Image size 2352x1568, 45° FOV — 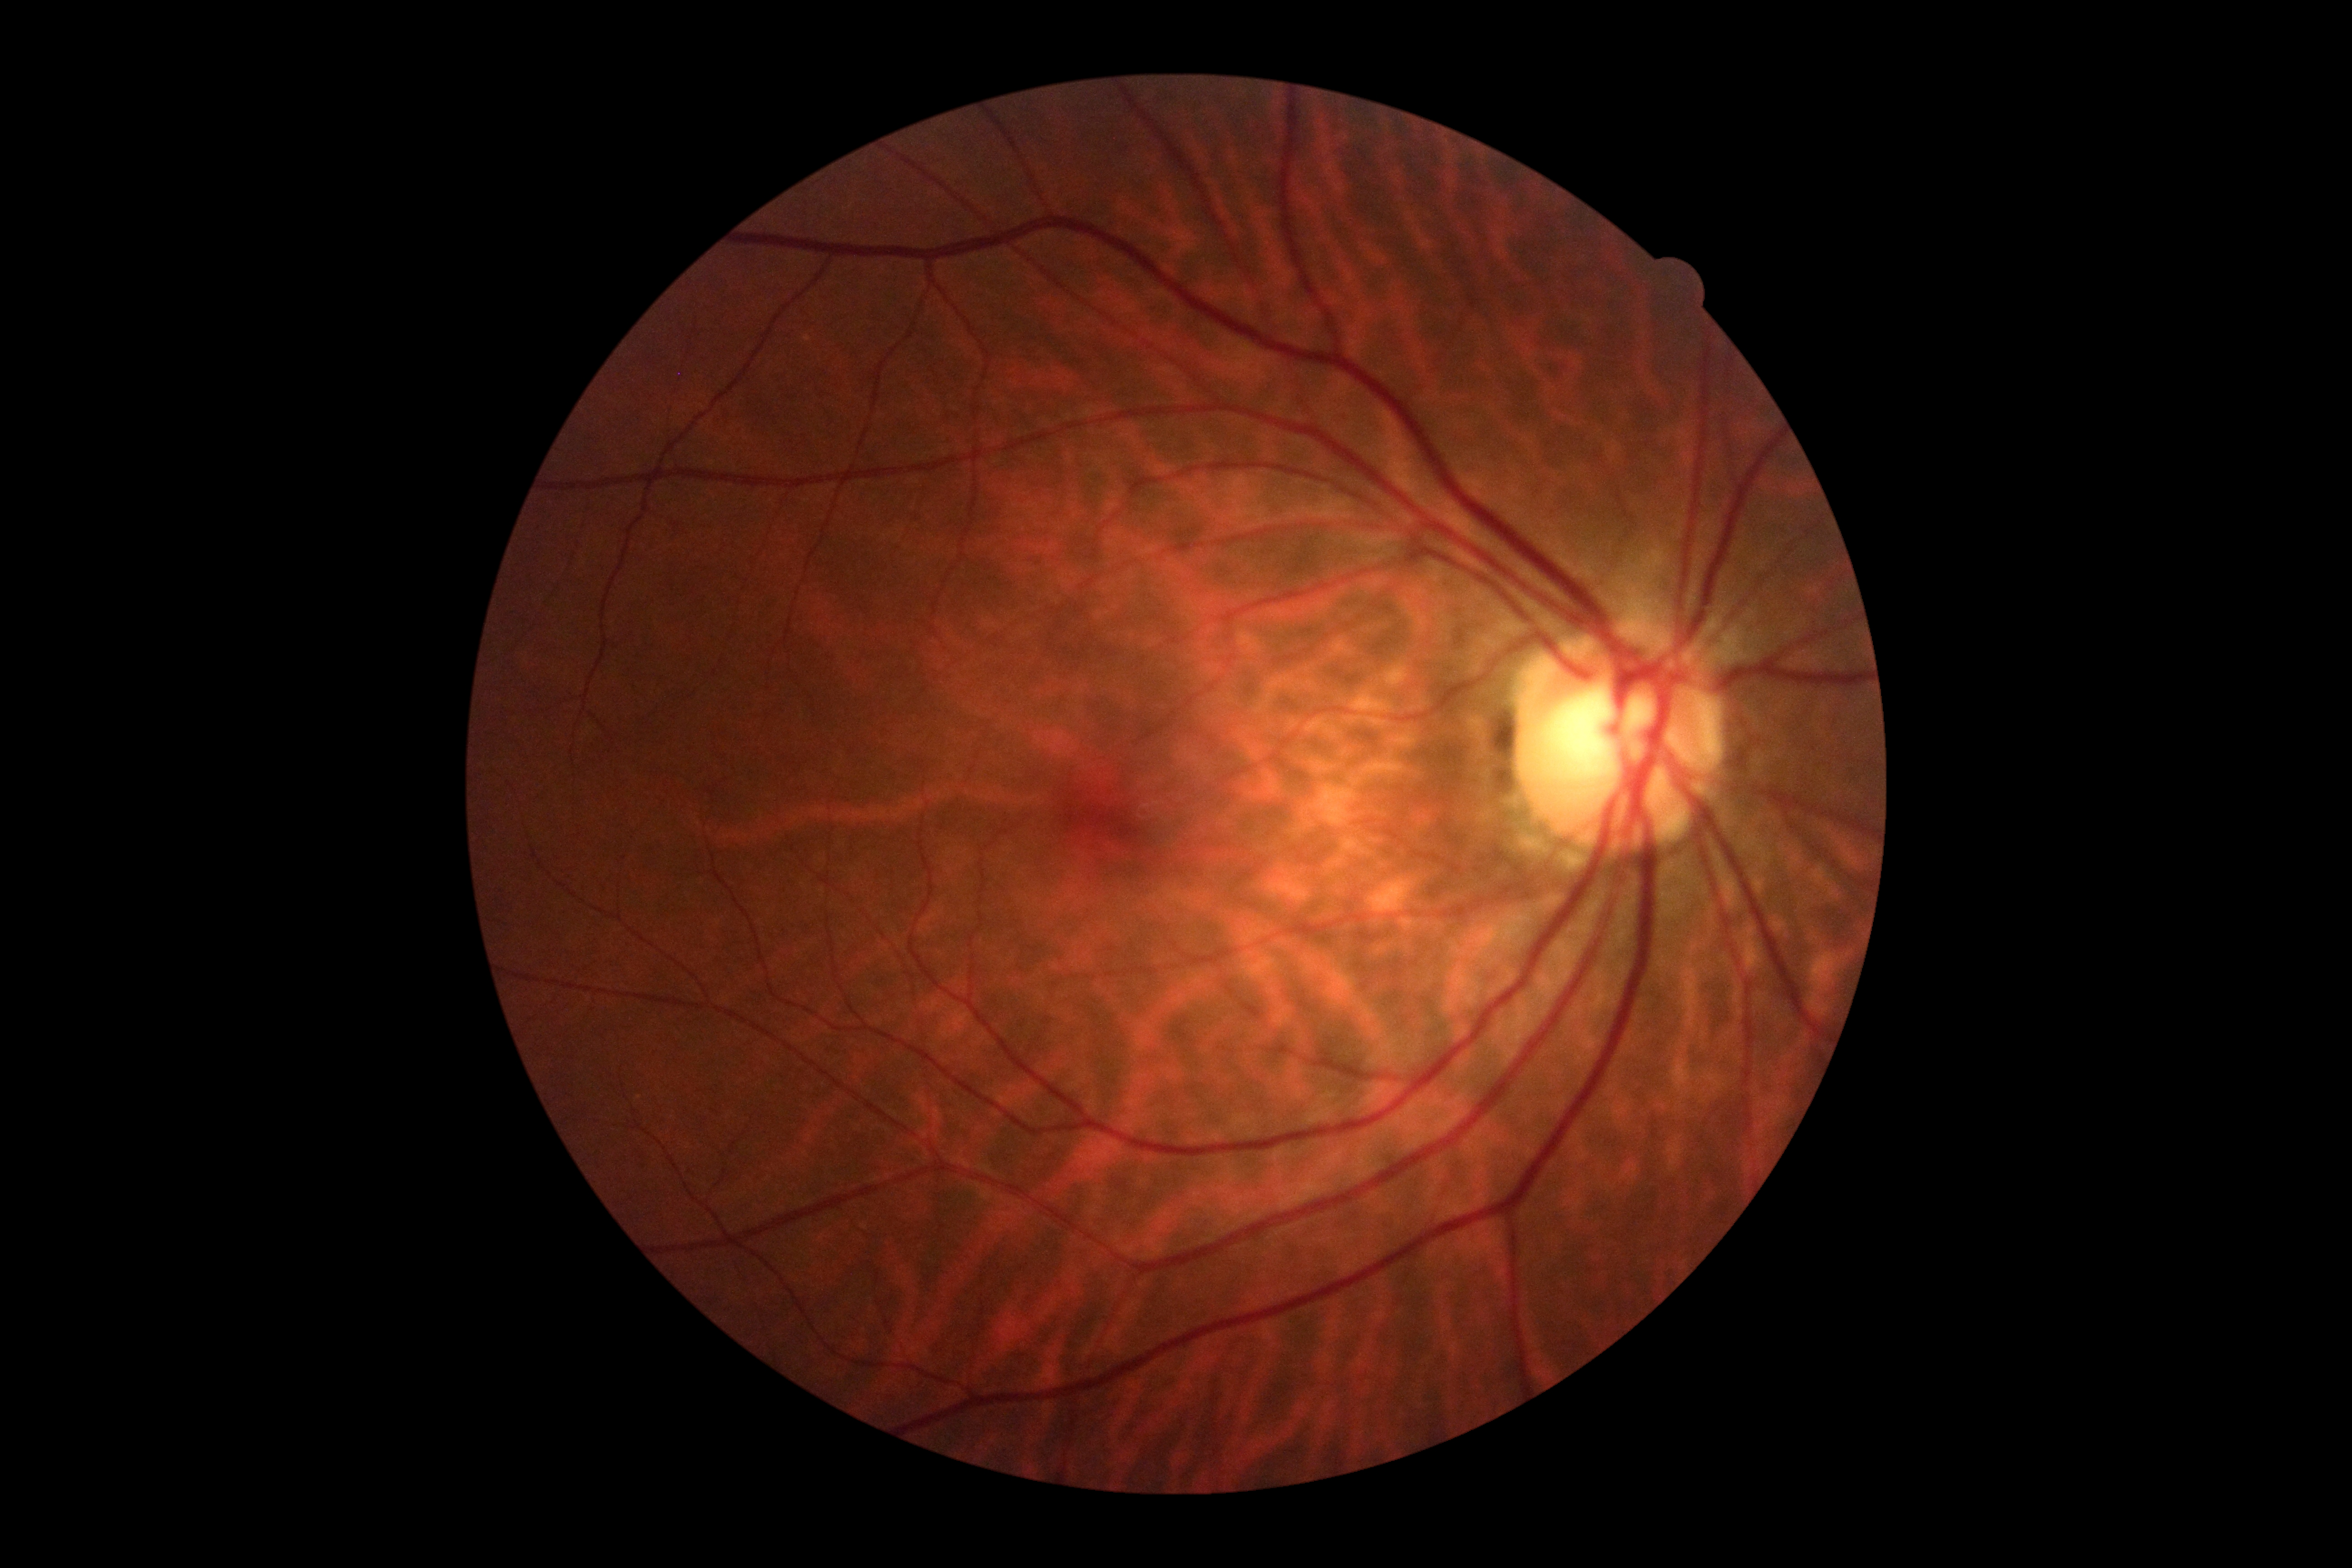

Diabetic retinopathy (DR): grade 0 (no apparent retinopathy).